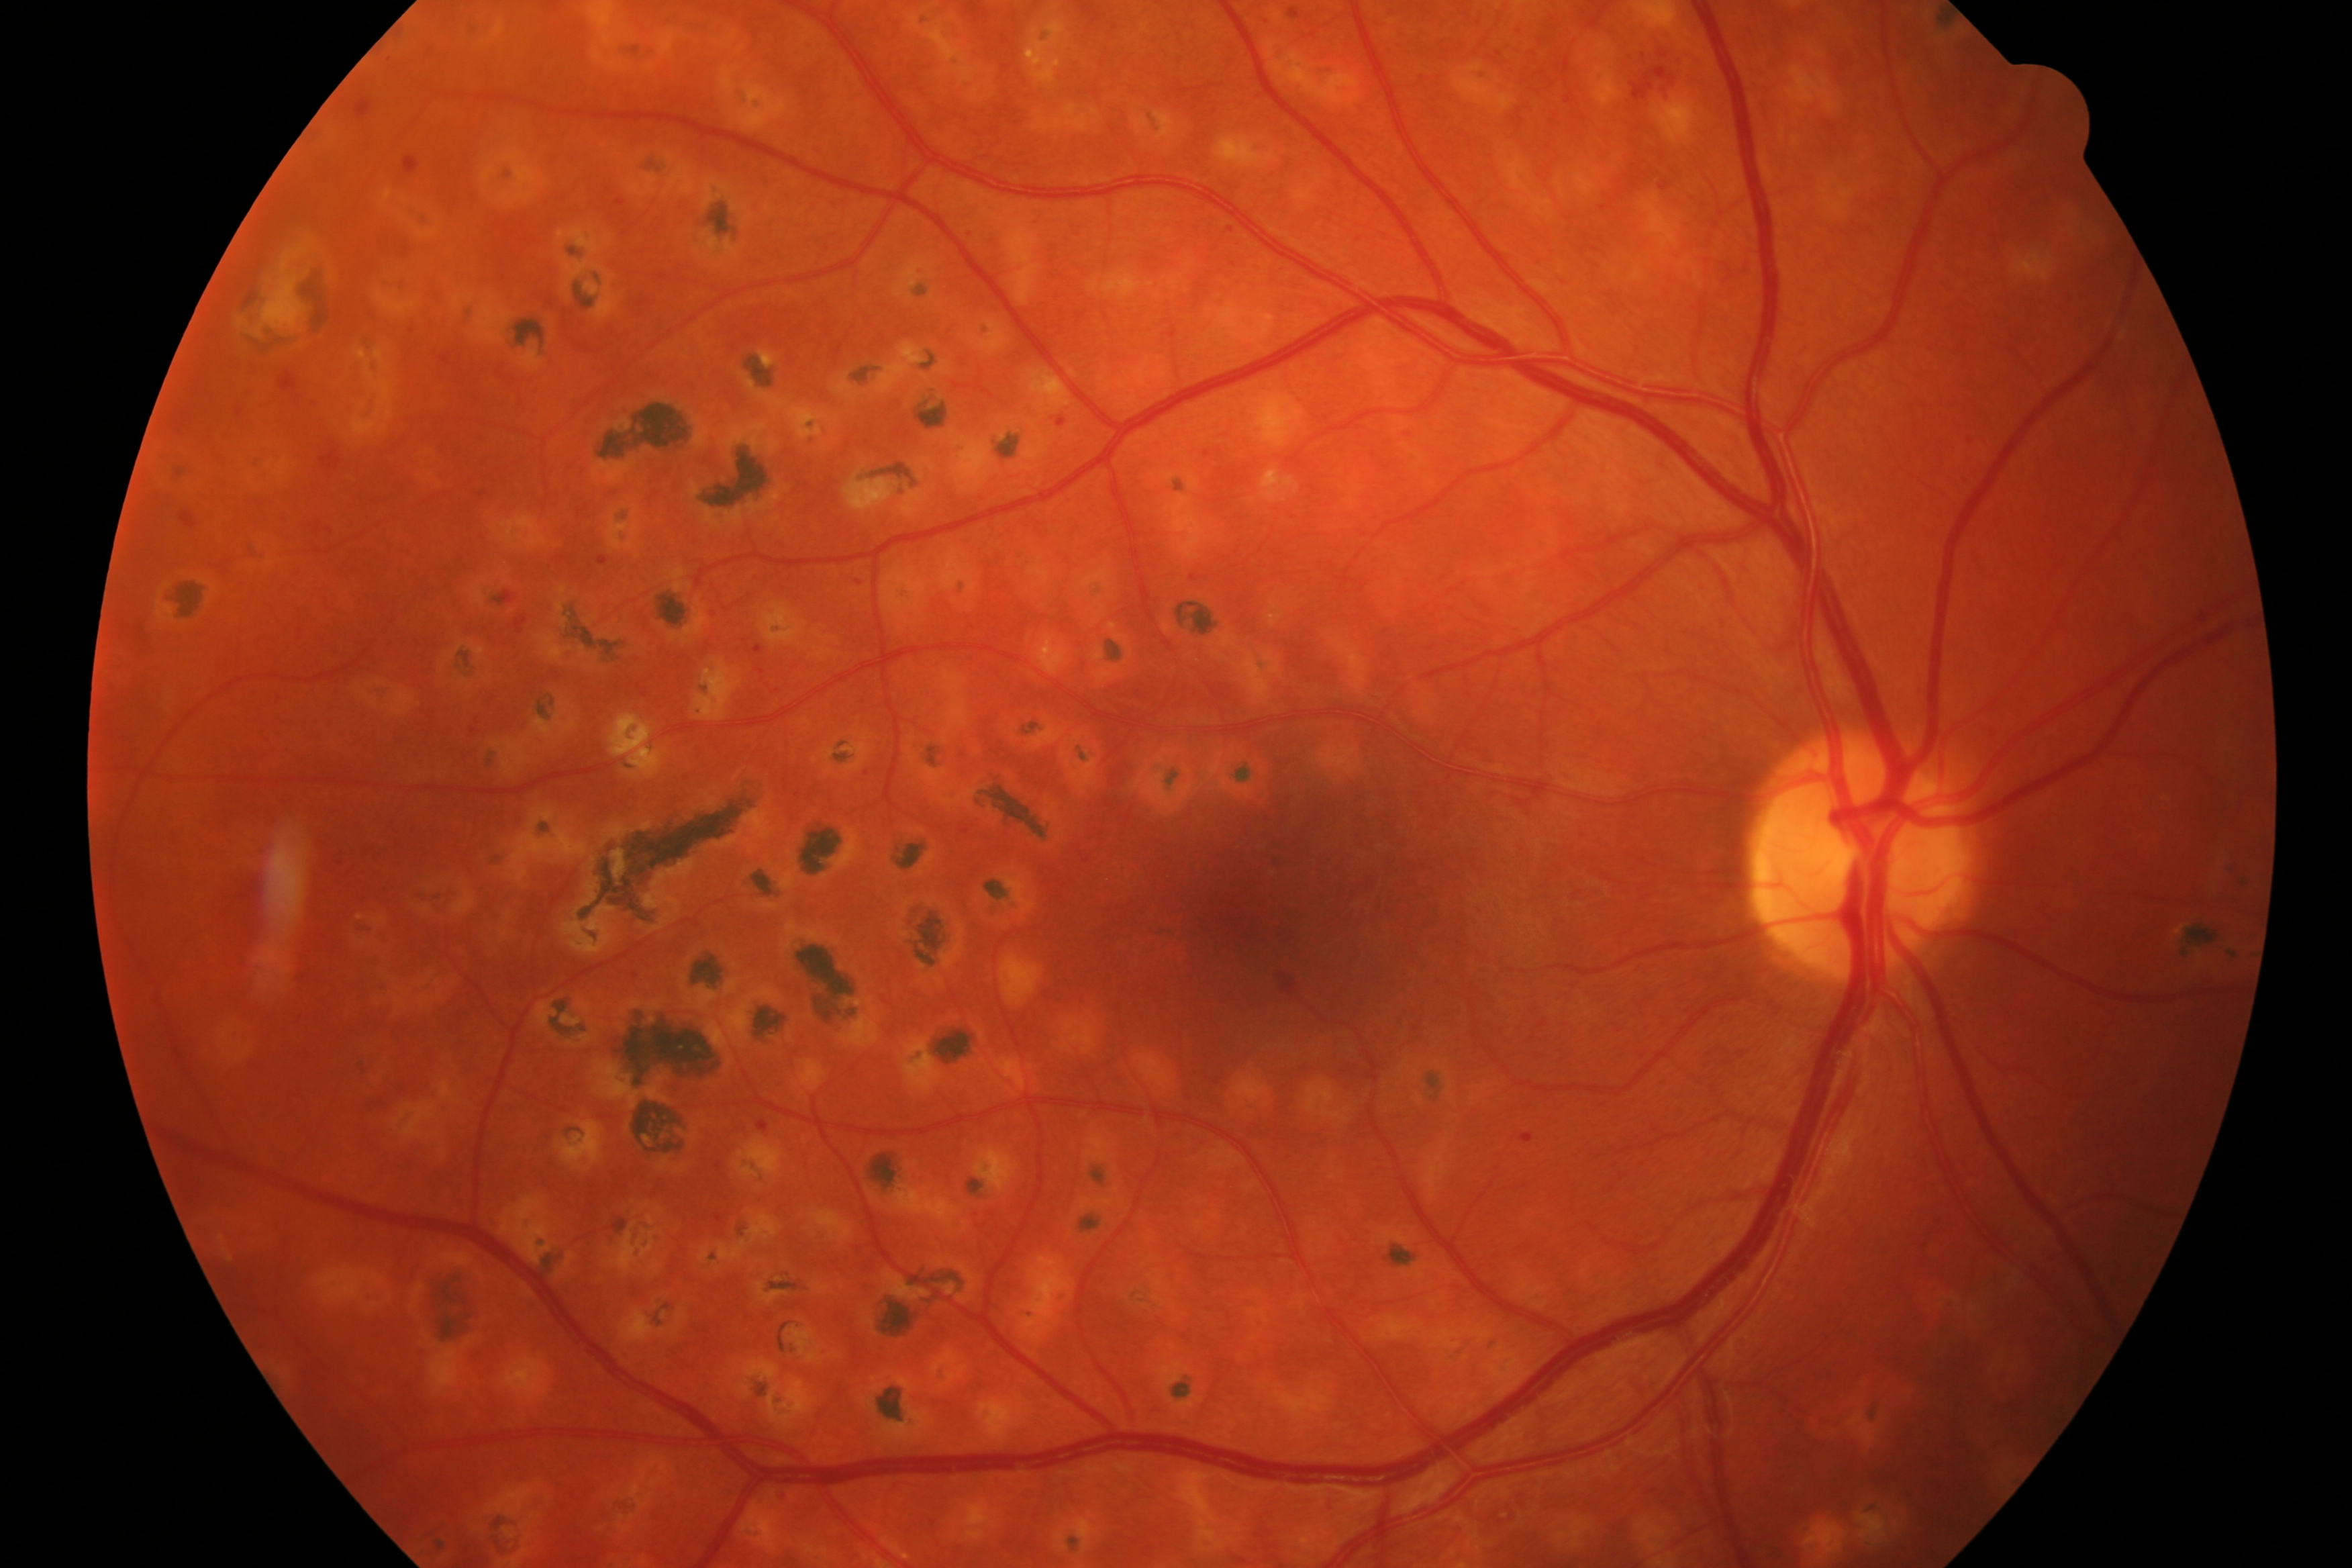 Impression: diabetic retinopathy.